CFP. Camera: NIDEK AFC-230. Graded on the modified Davis scale. Without pupil dilation — 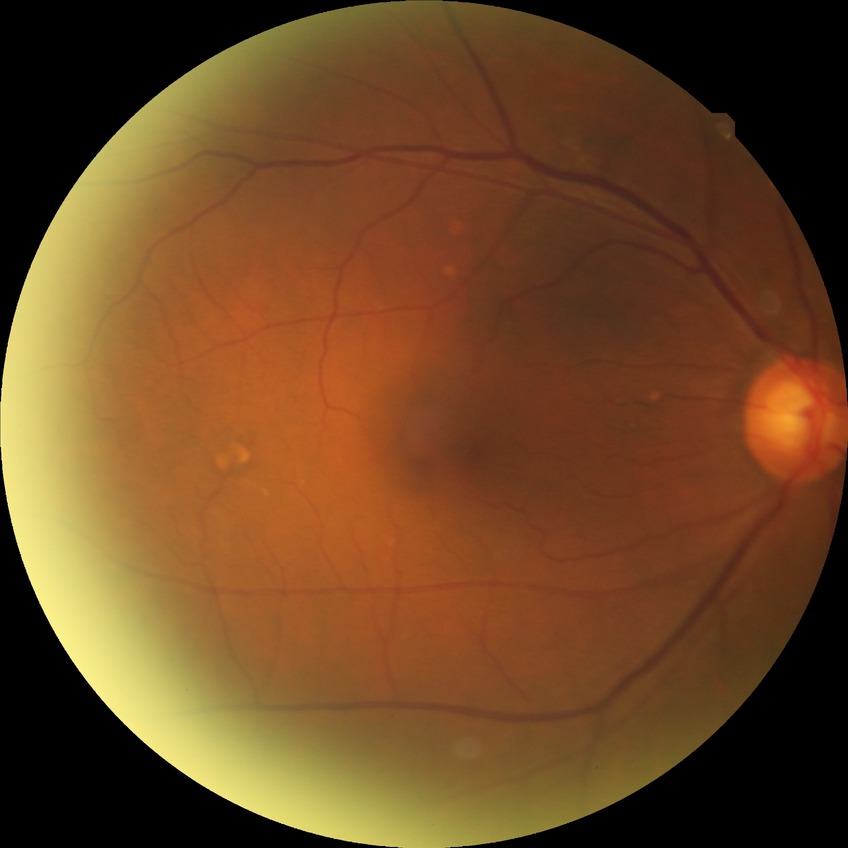

Modified Davis classification: no diabetic retinopathy.